Wide-field fundus image from infant ROP screening.
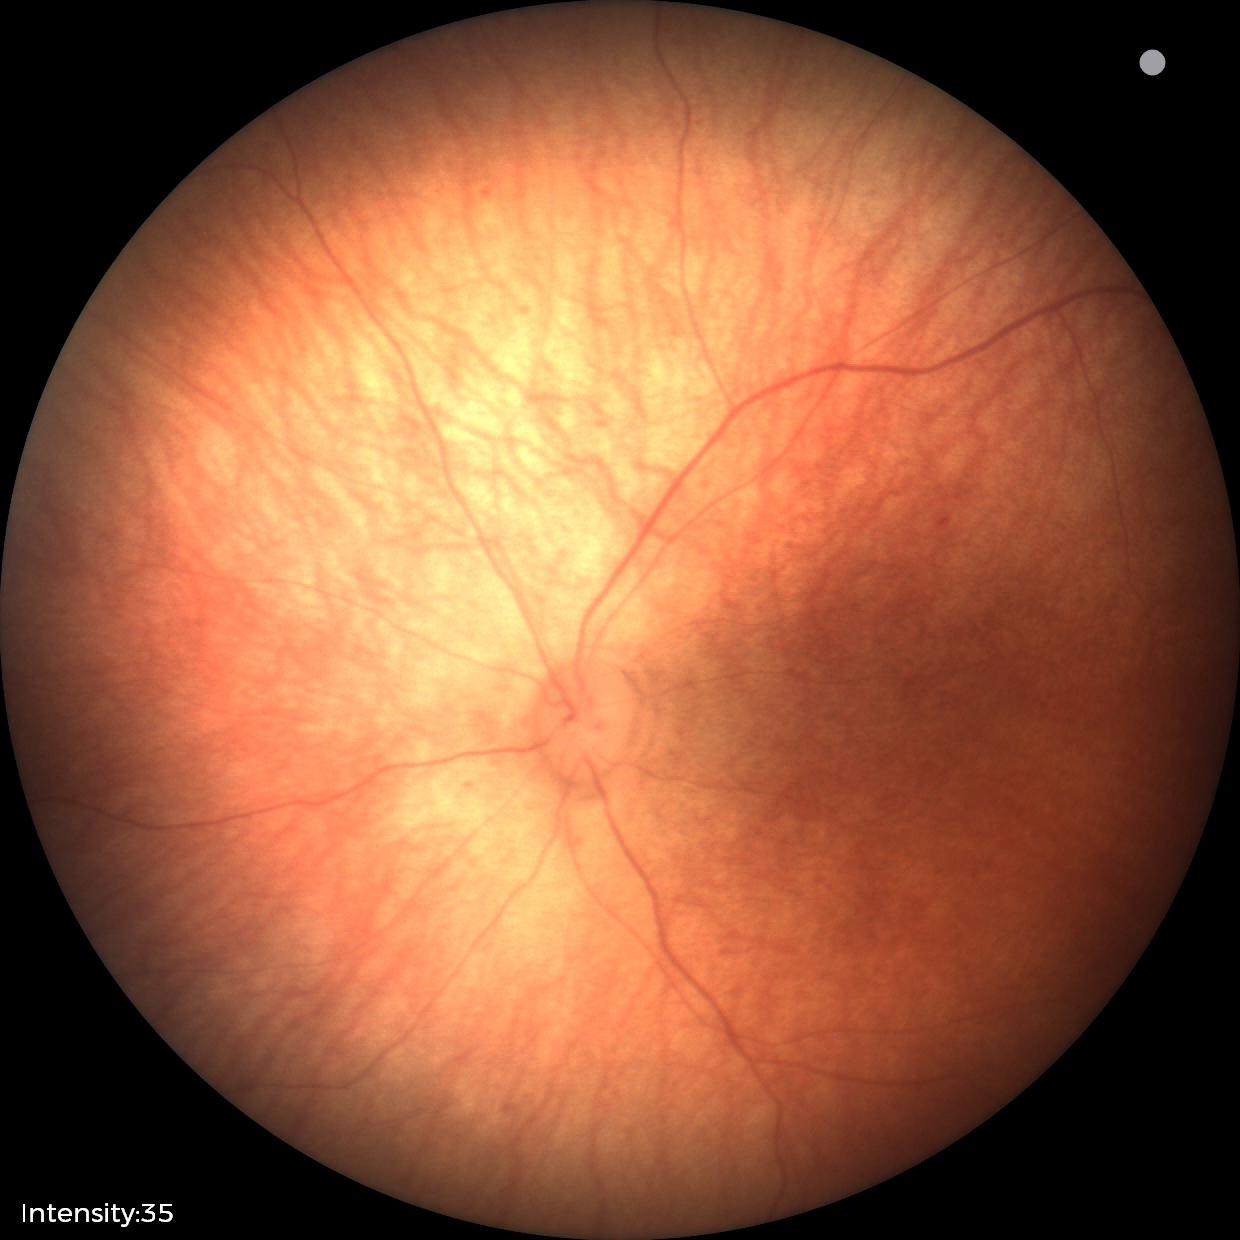 Q: What was the screening finding?
A: no abnormal retinal findings